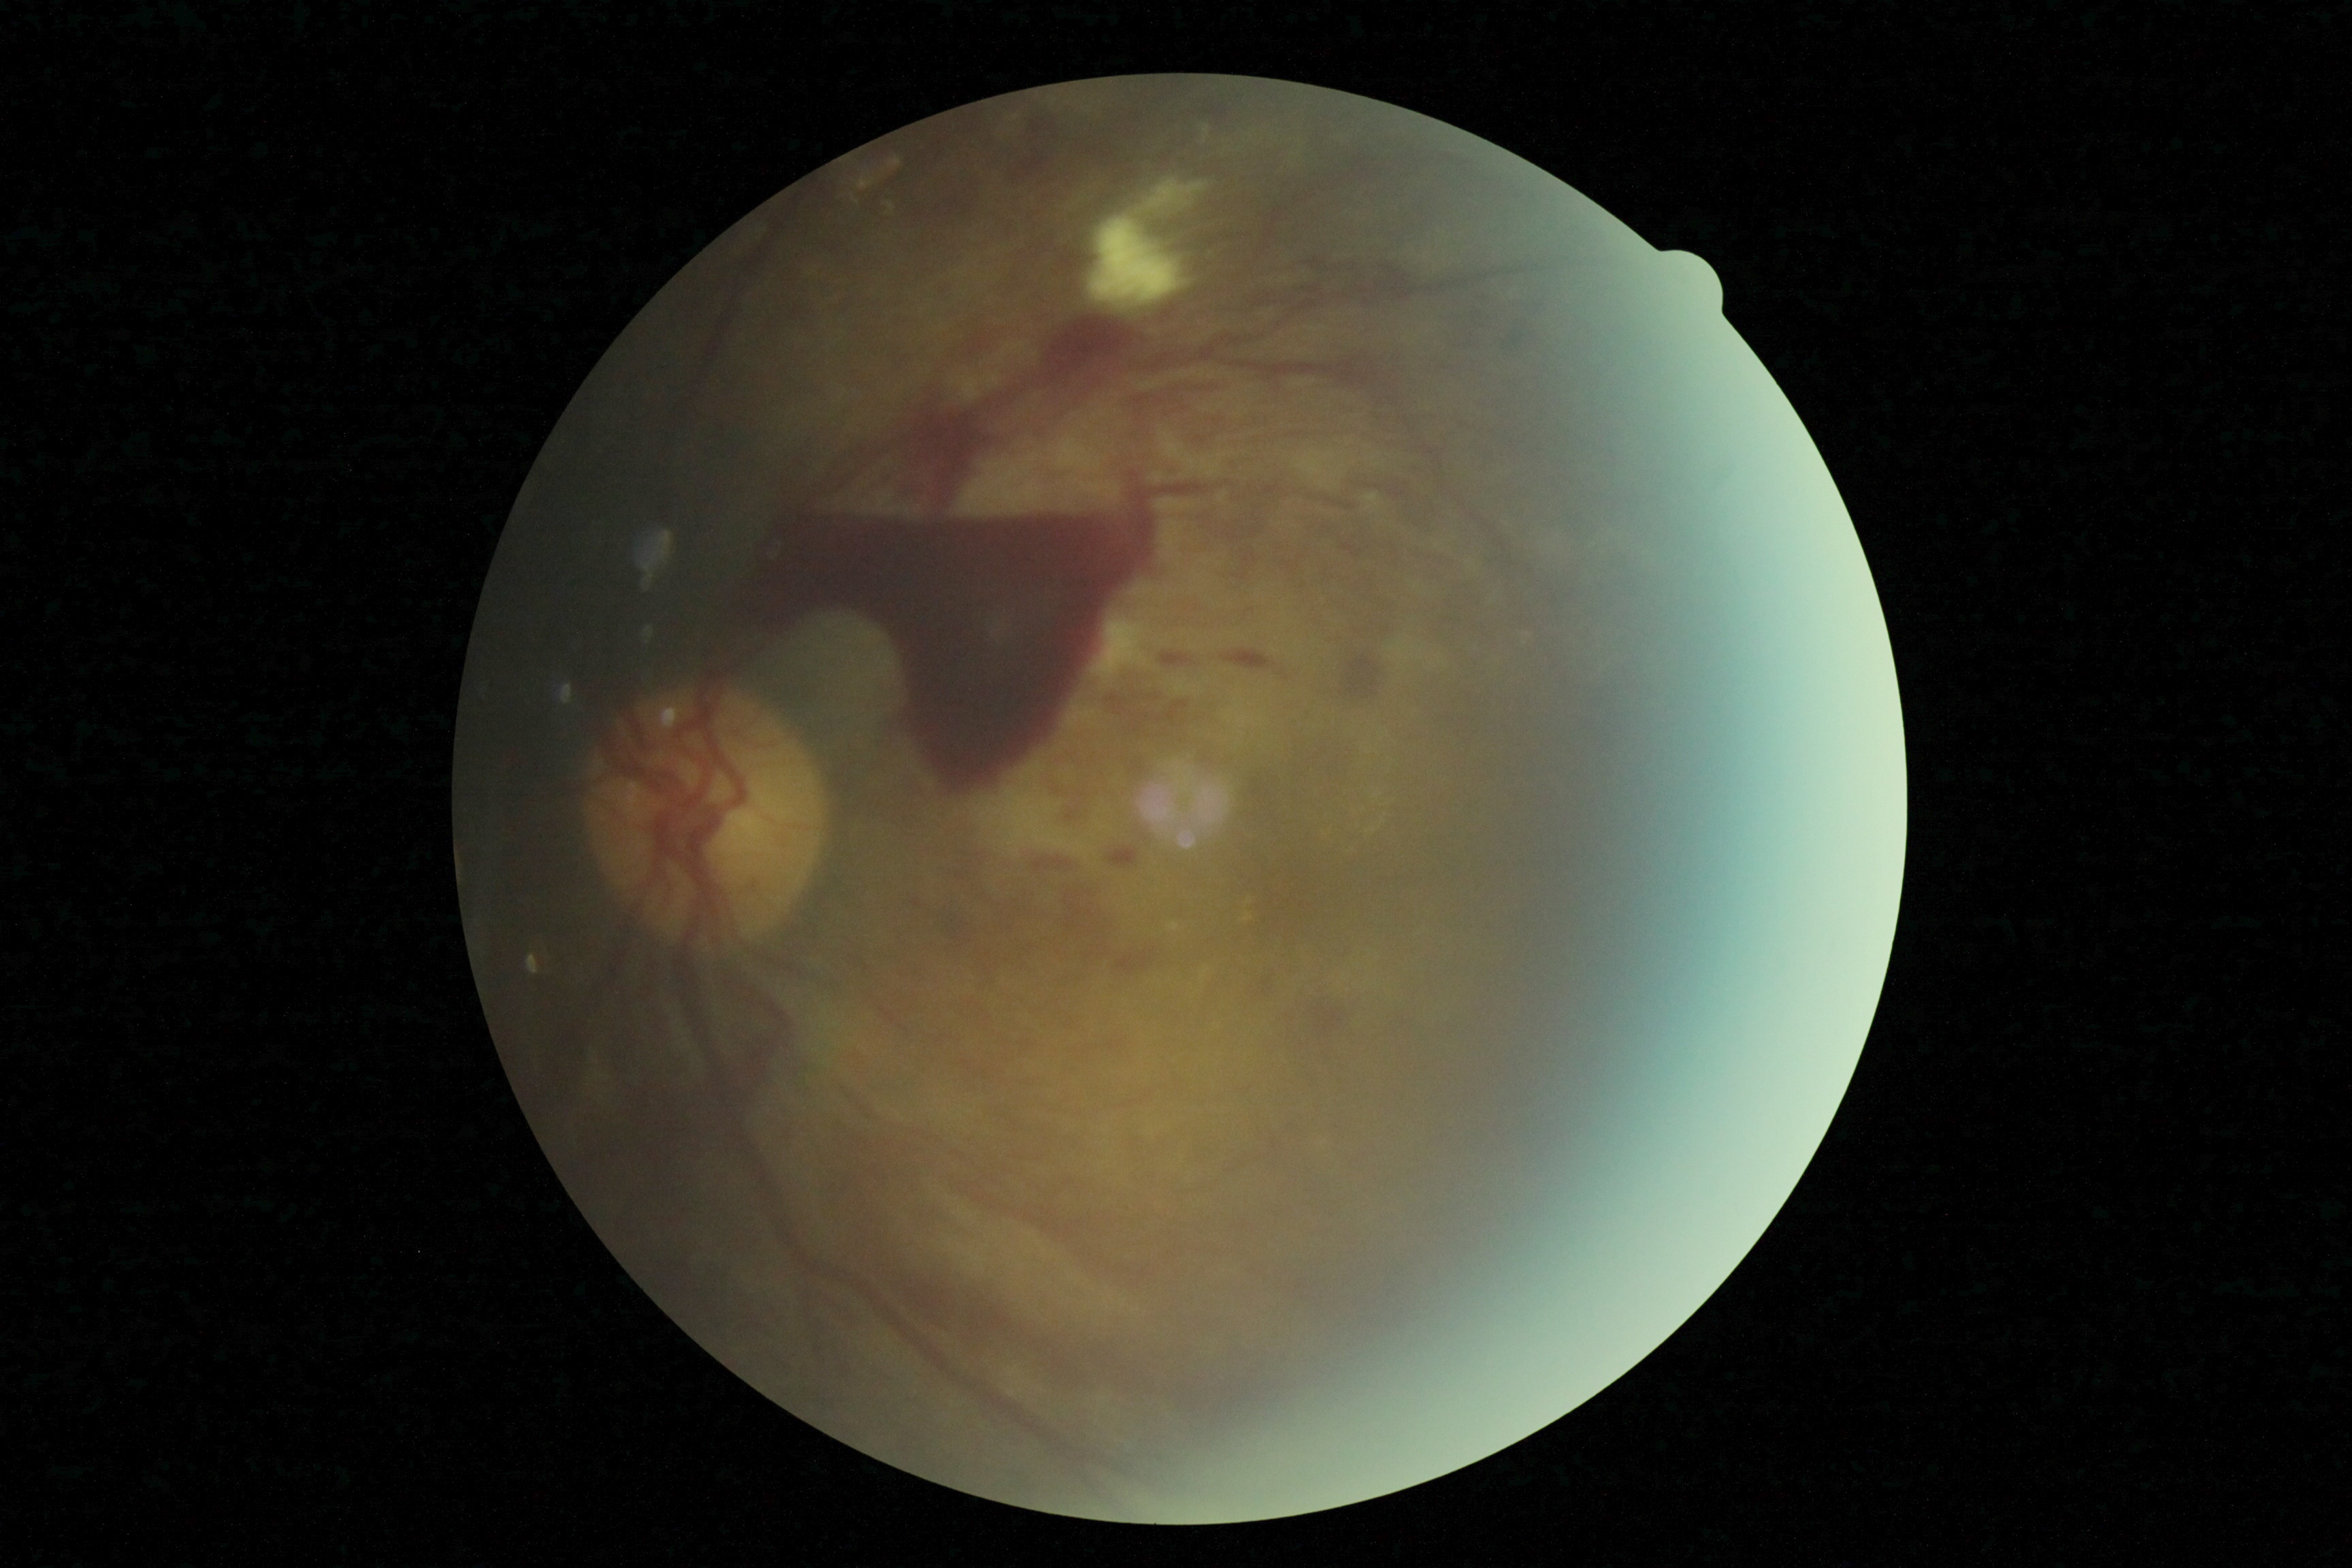
Retinopathy is grade 4 (PDR).